DR severity per modified Davis staging:
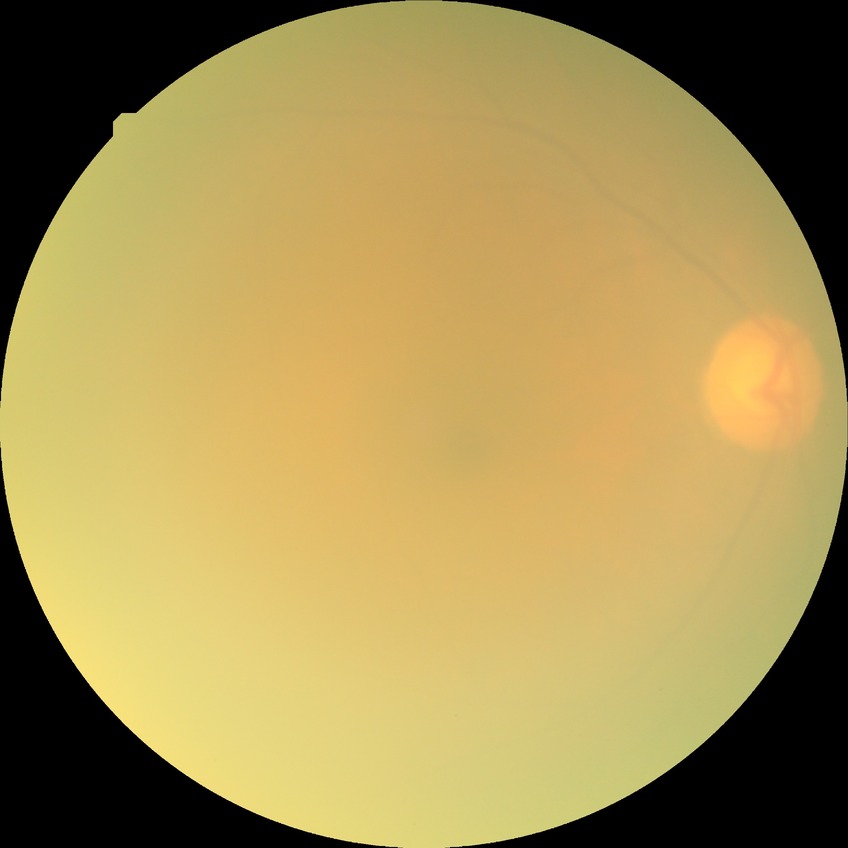

Annotations:
• modified Davis grading — no diabetic retinopathy